Wide-field fundus photograph from neonatal ROP screening; 130° field of view (Clarity RetCam 3); image size 640x480
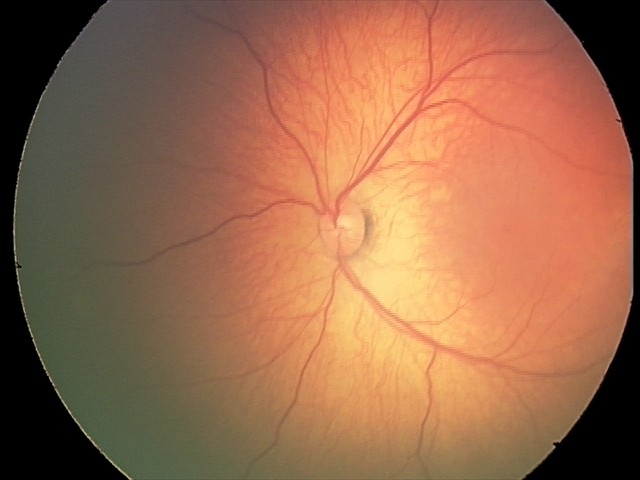
Assessment: physiological retinal finding.